Fundus photo, 45-degree field of view
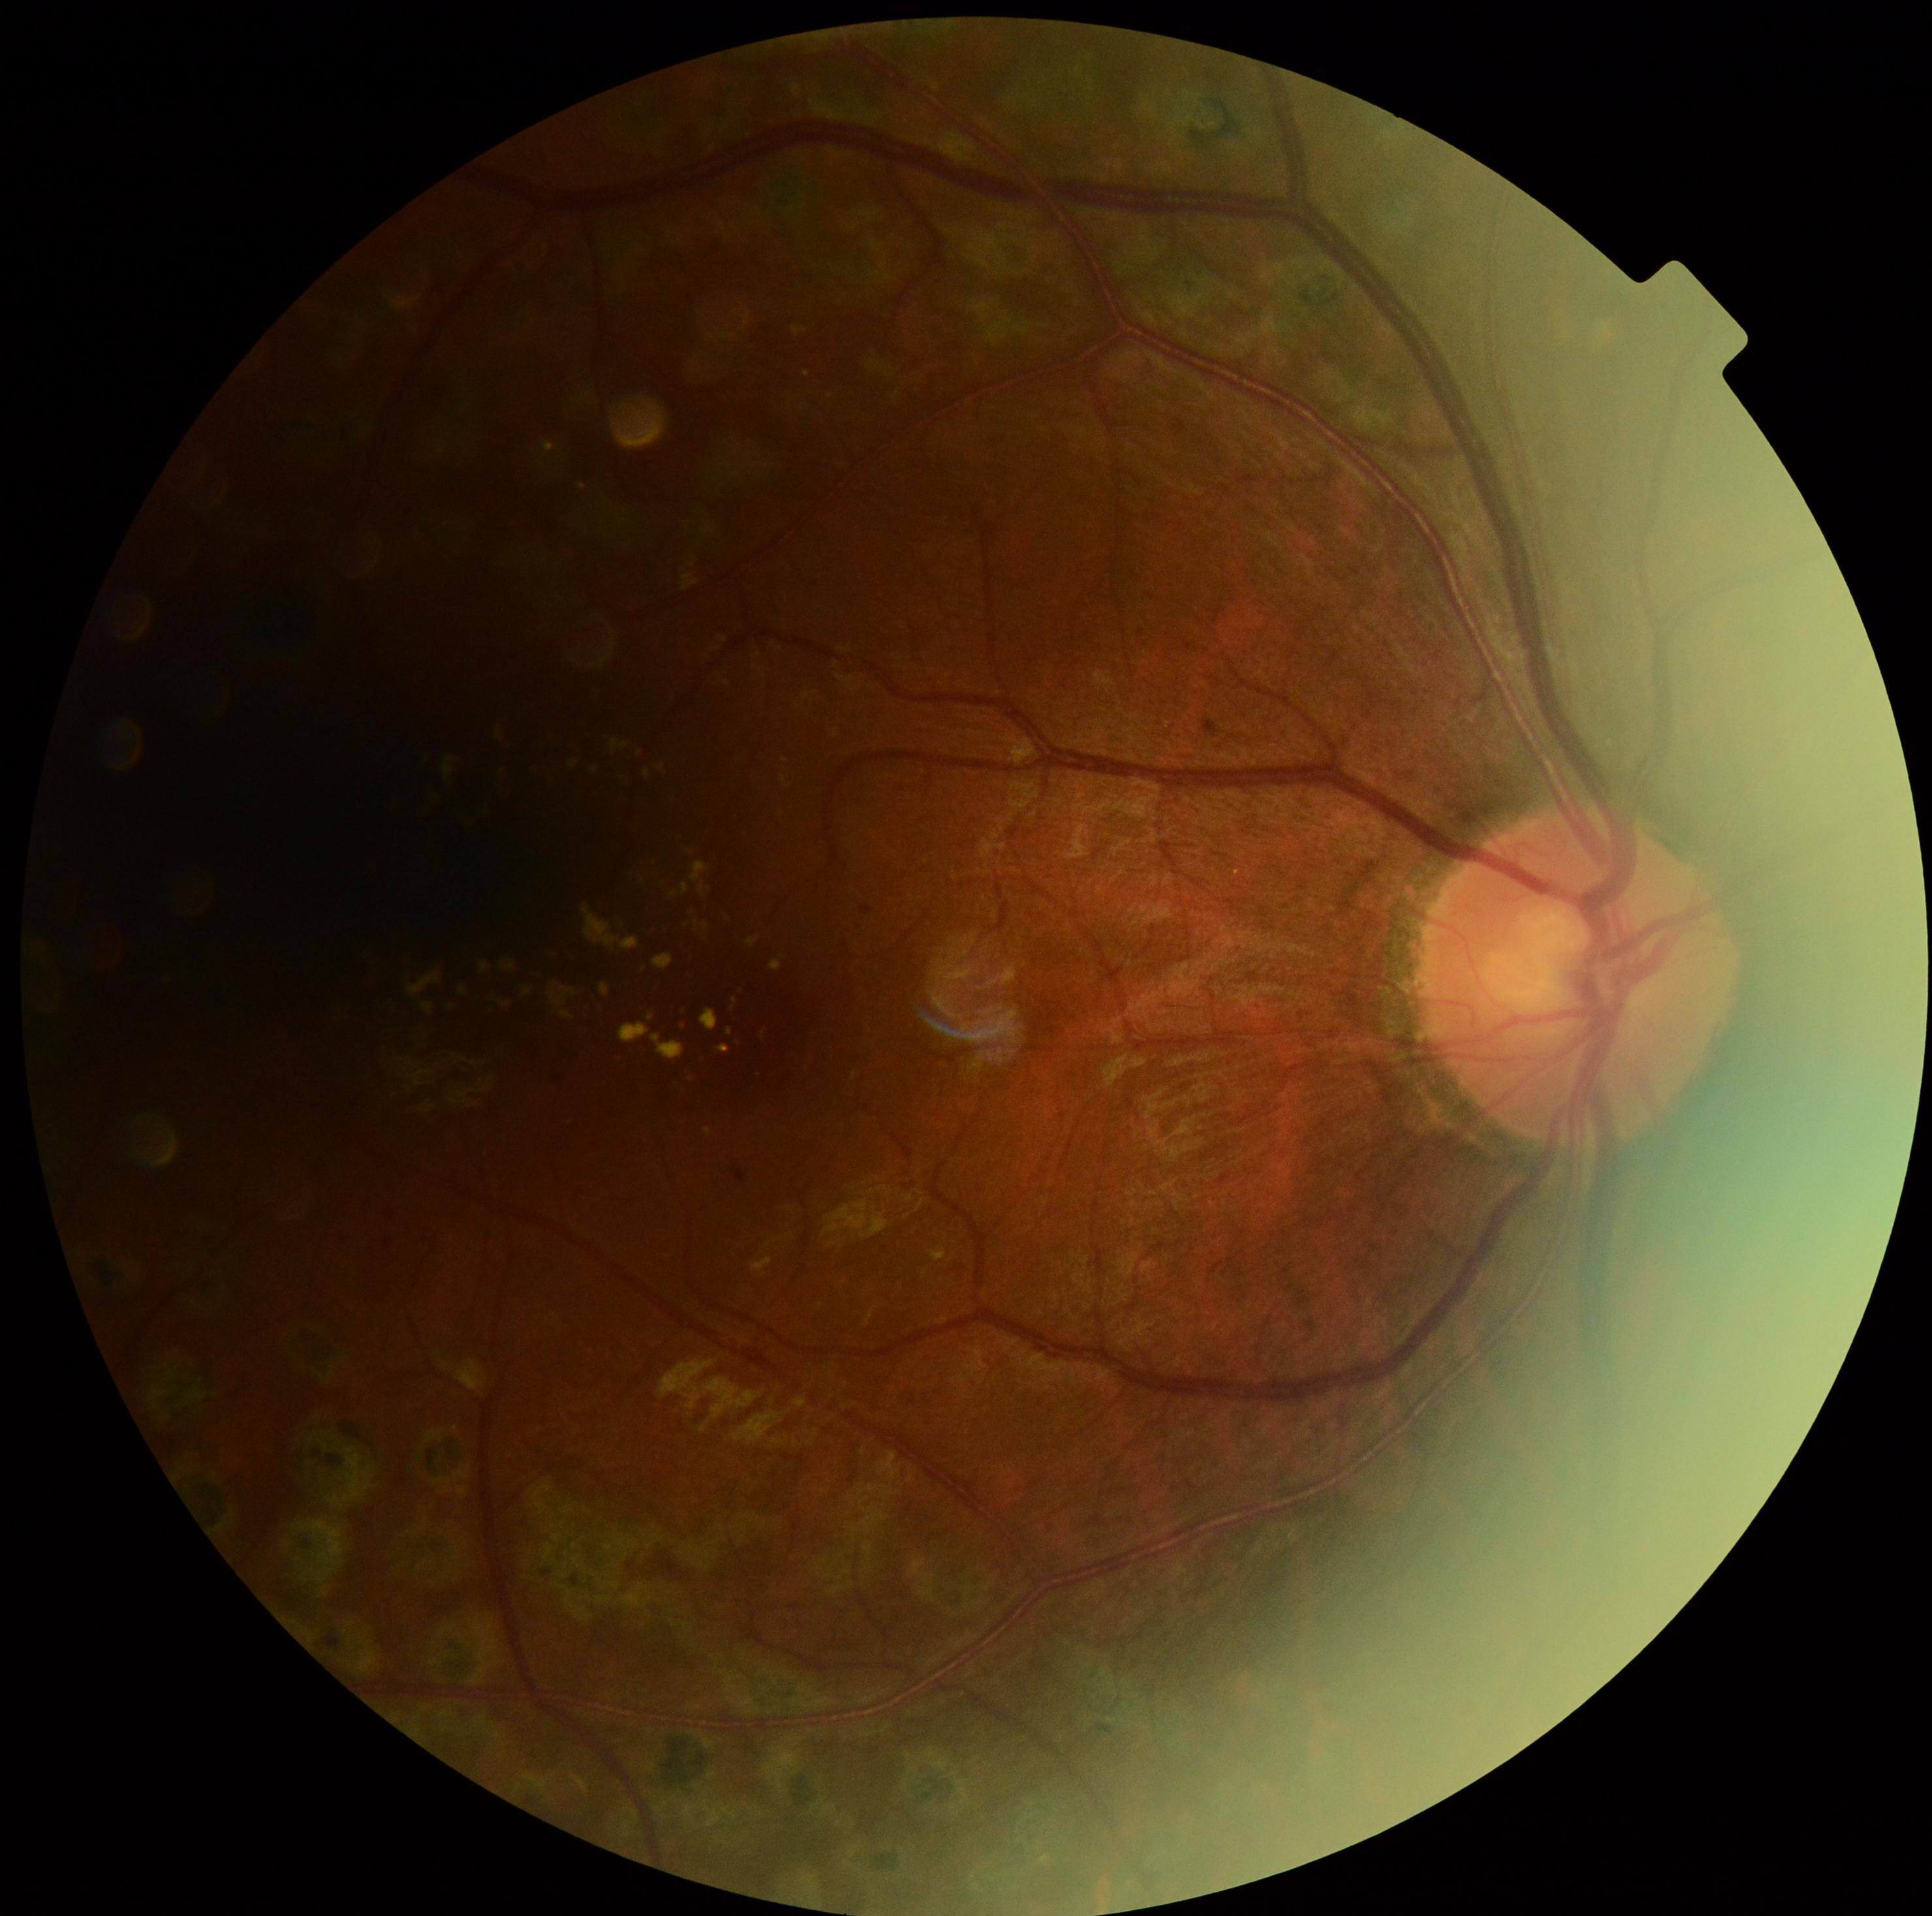 Diabetic retinopathy is moderate non-proliferative diabetic retinopathy (grade 2).